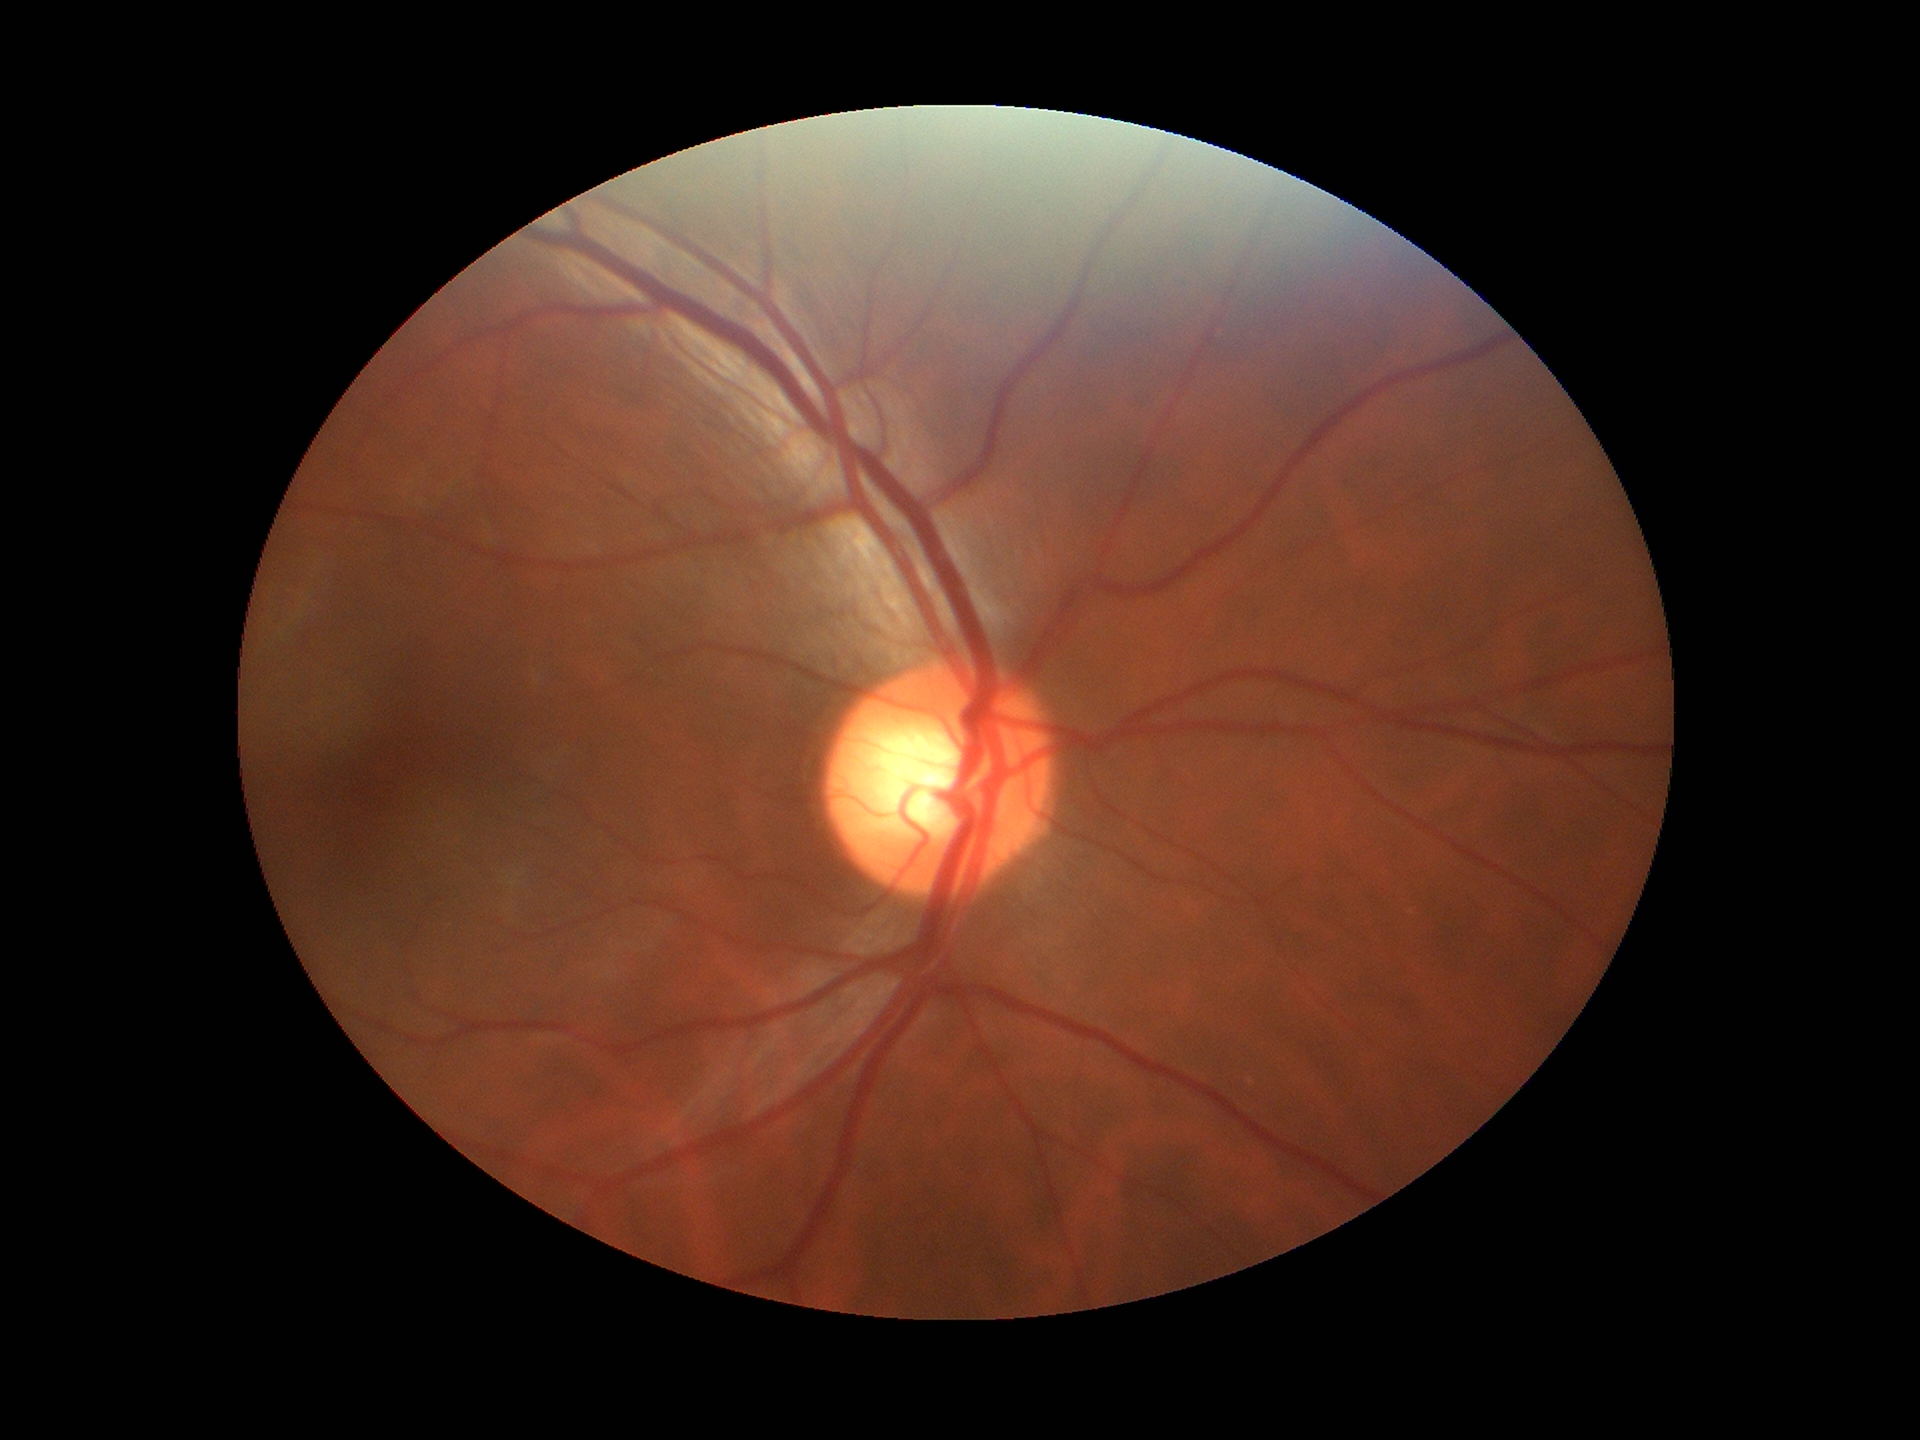 Glaucoma impression: no suspicious findings. Vertical C/D ratio is 0.57.